CFP. 45-degree field of view. Image size 2352x1568
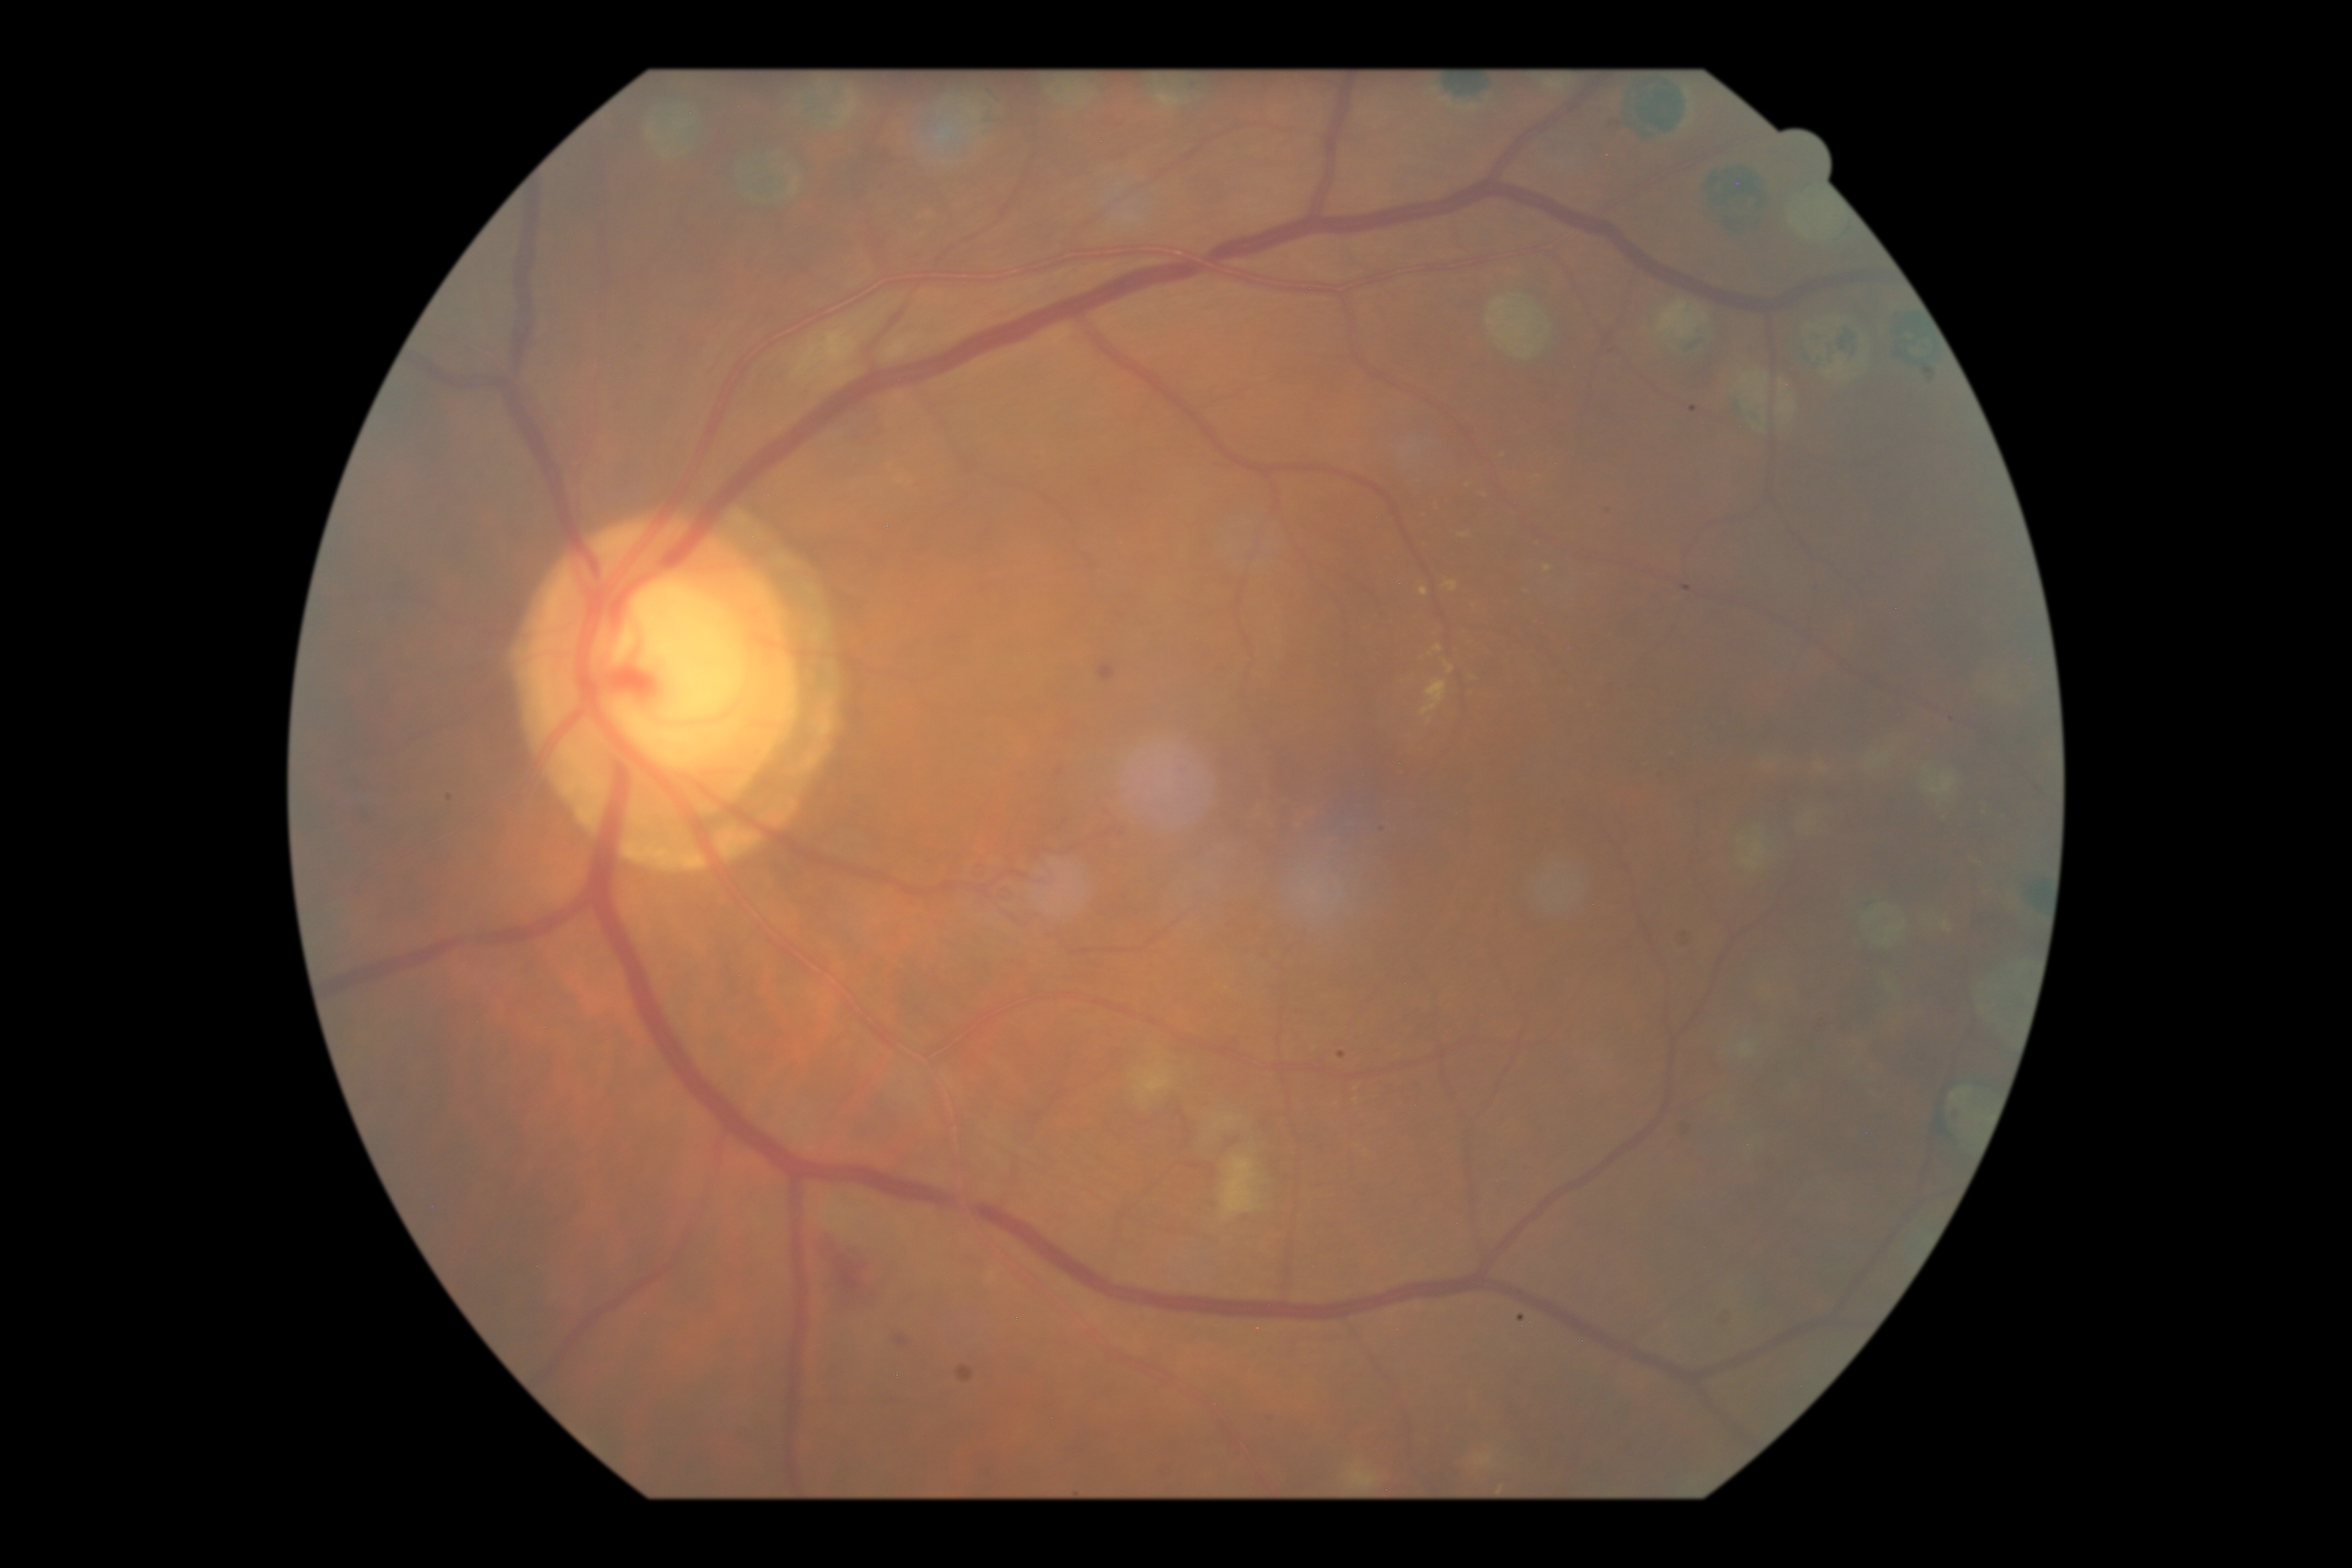

Diabetic retinopathy (DR) is moderate non-proliferative diabetic retinopathy (grade 2)
microaneurysms (MAs): (1017,765,1025,778), (1099,665,1115,681), (1055,765,1067,777), (897,1336,908,1346)
hard exudates (EXs): (1460,534,1469,539), (1469,672,1477,677), (1499,450,1511,458), (1422,680,1448,718), (1532,476,1540,483), (1545,566,1553,574), (1480,491,1492,500), (1421,587,1429,598), (1445,582,1459,593), (1434,646,1442,653), (1433,503,1438,511), (1534,543,1545,551), (1445,663,1456,675)
Small EXs approximately at x=1430 y=721, x=1431 y=655, x=1467 y=695
soft exudates (SEs): (1221,1157,1263,1224), (791,322,857,385), (1190,1107,1259,1153), (1134,1063,1174,1103)
hemorrhages (HEs): (818,1240,885,1314)